45-degree field of view; color fundus image
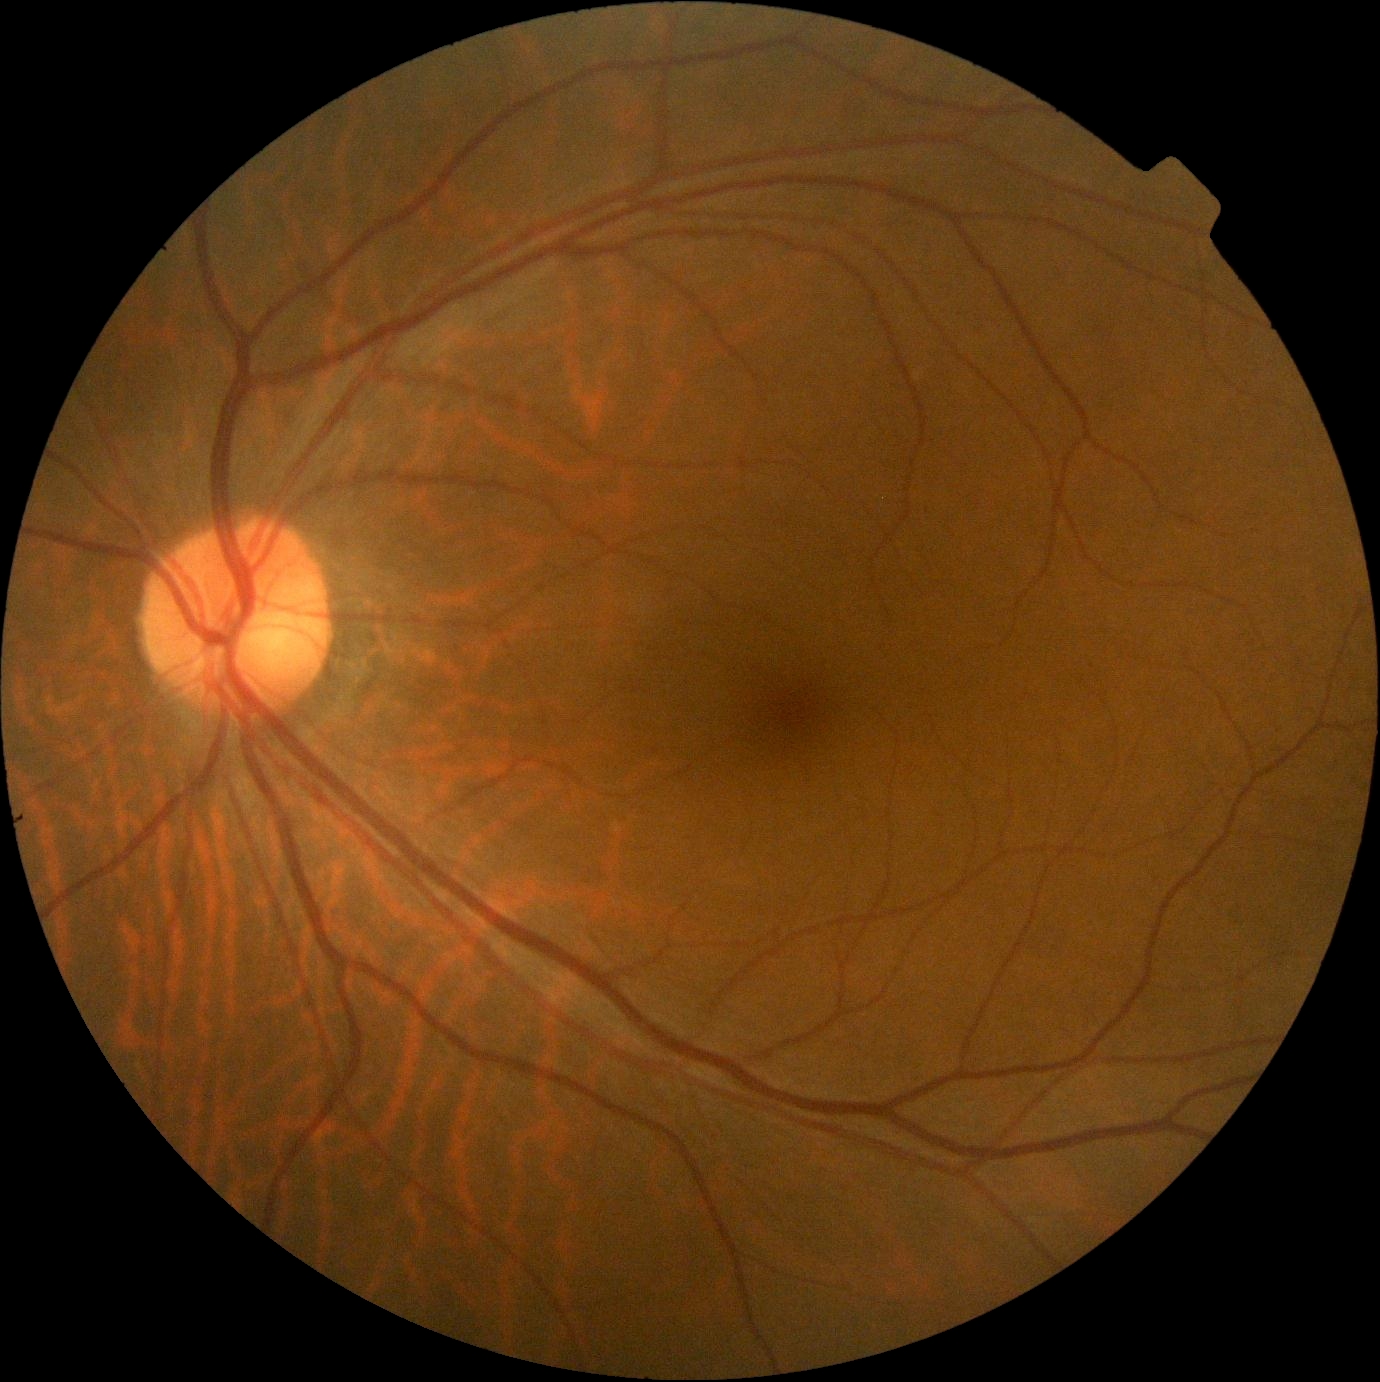
diabetic retinopathy grade: 0.